Posterior pole color fundus photograph · acquired with a NIDEK AFC-230 · no pharmacologic dilation · 45 degree fundus photograph: 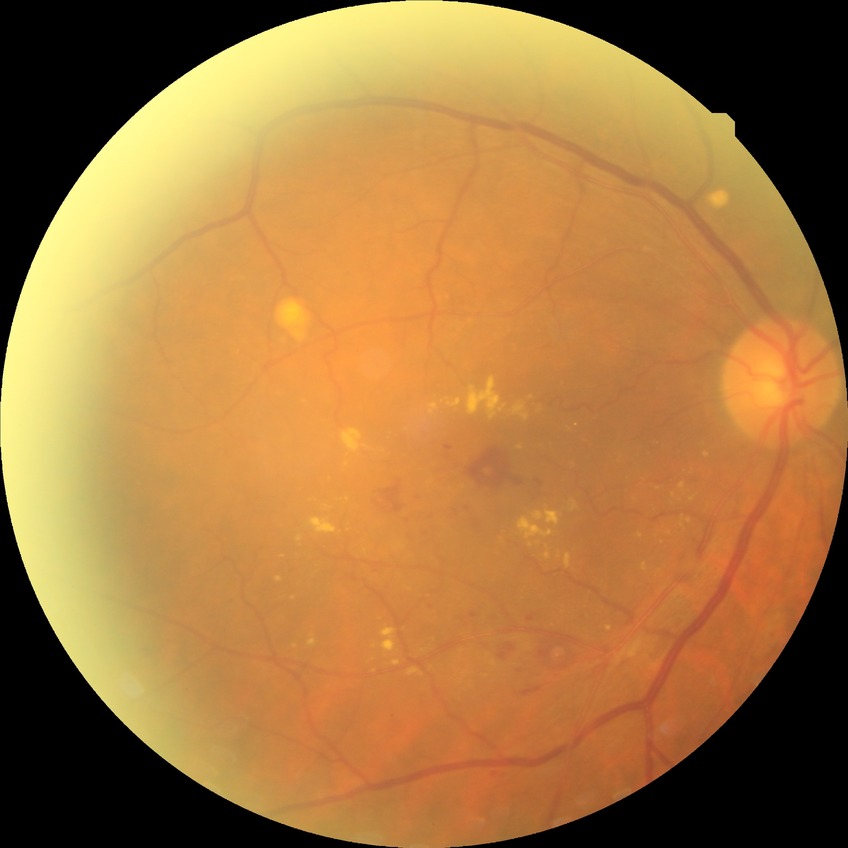 Diabetic retinopathy grade: simple diabetic retinopathy.